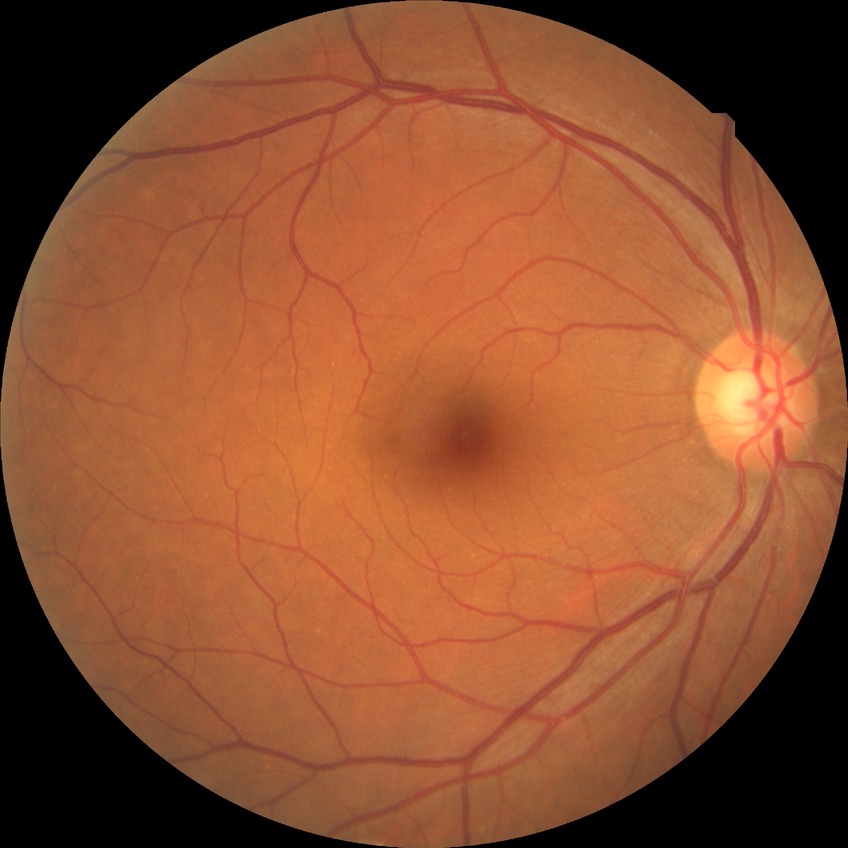 diabetic retinopathy grade = no diabetic retinopathy